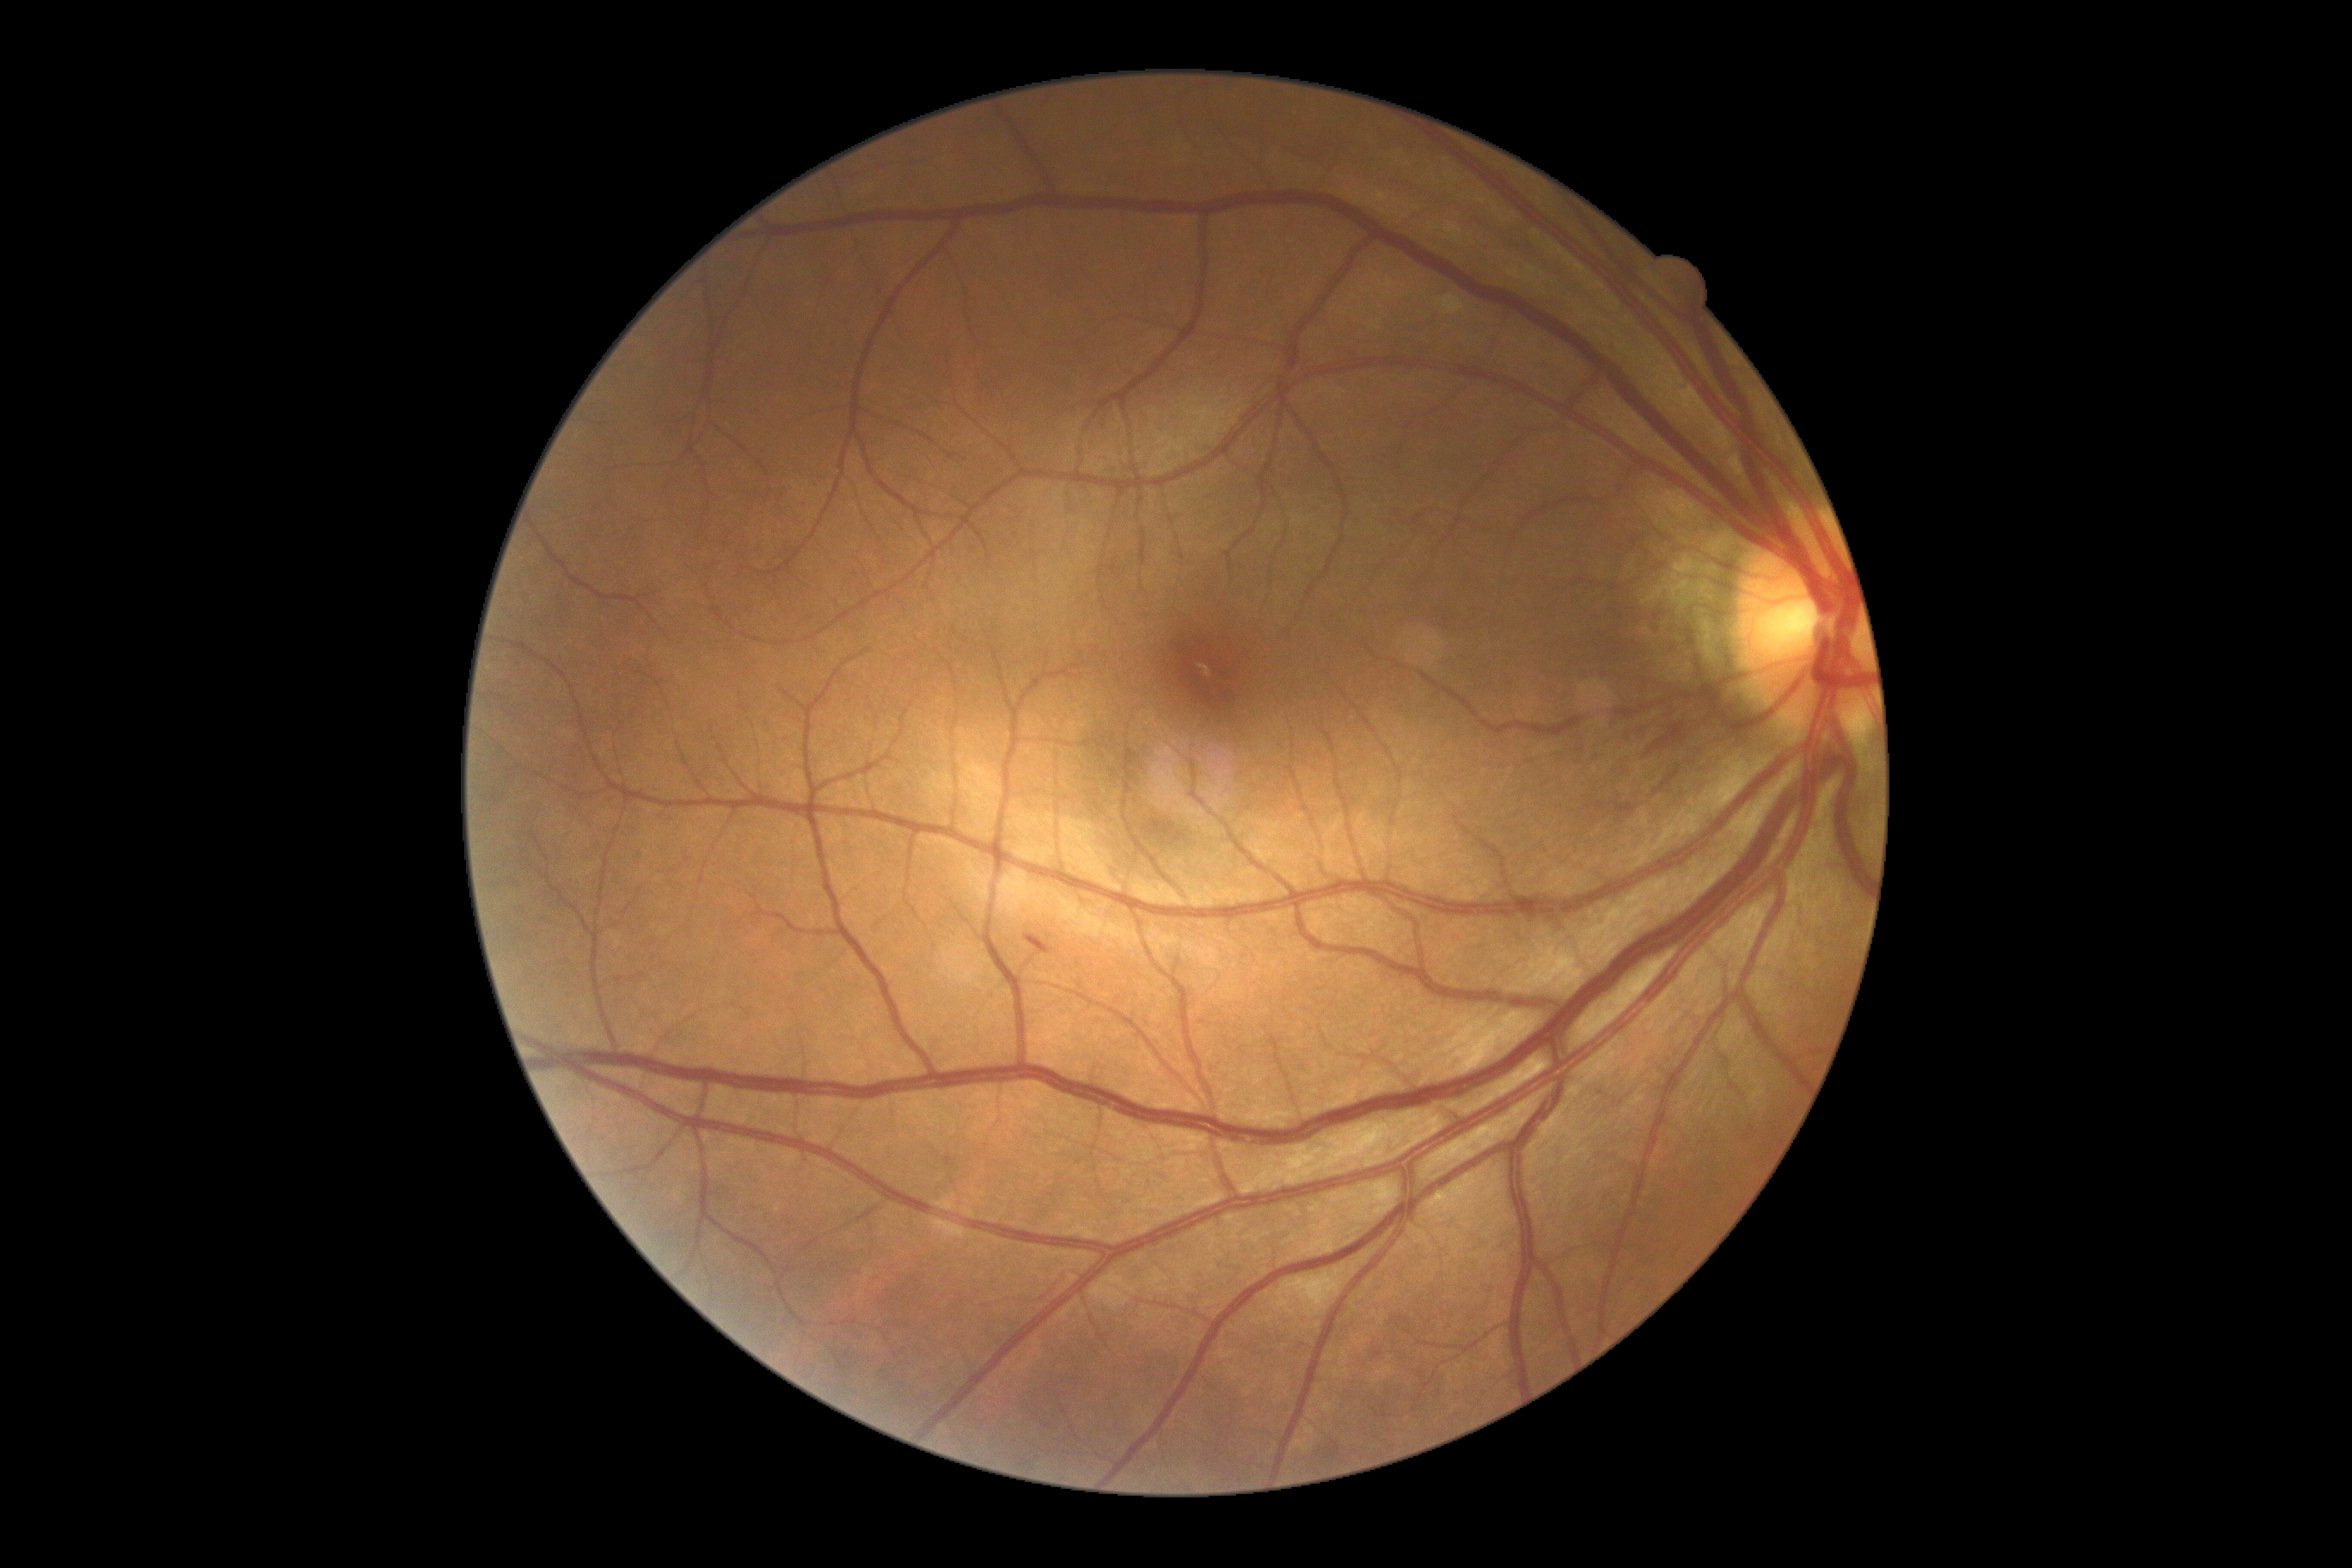 Findings:
* DR class: non-proliferative diabetic retinopathy
* DR grade: moderate non-proliferative diabetic retinopathy (2)